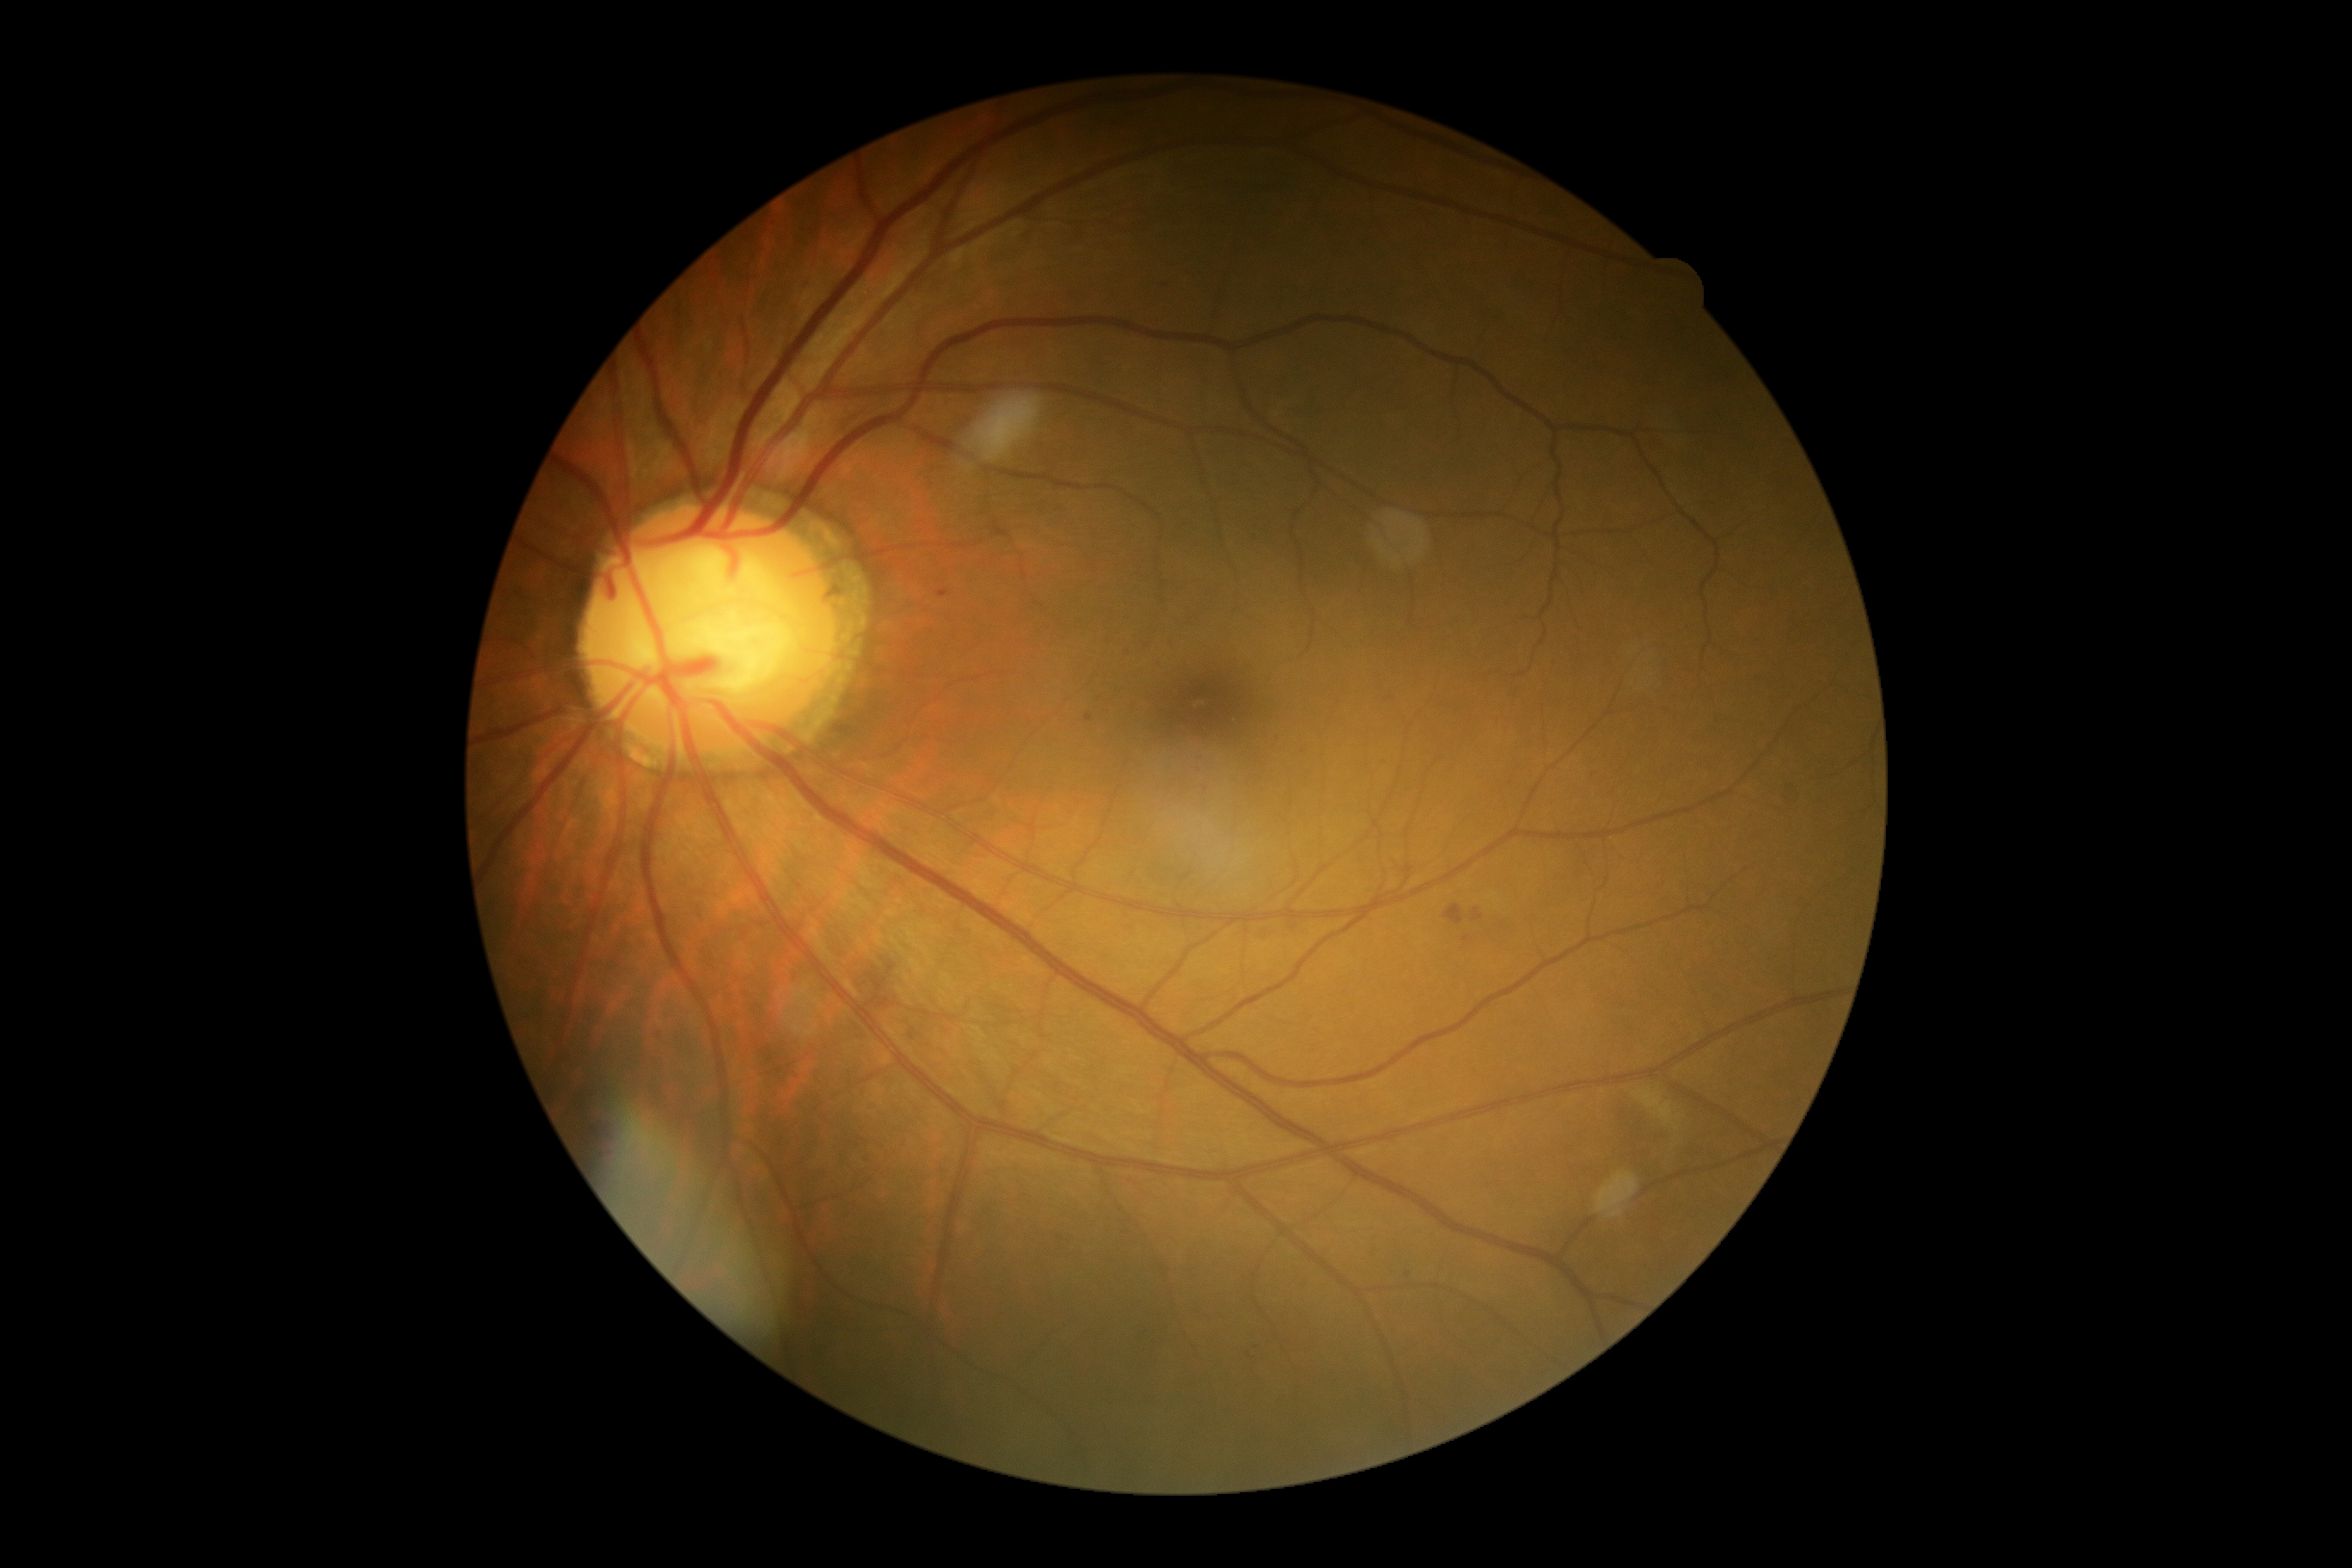
Annotations:
* DR grade — 2 (moderate NPDR)